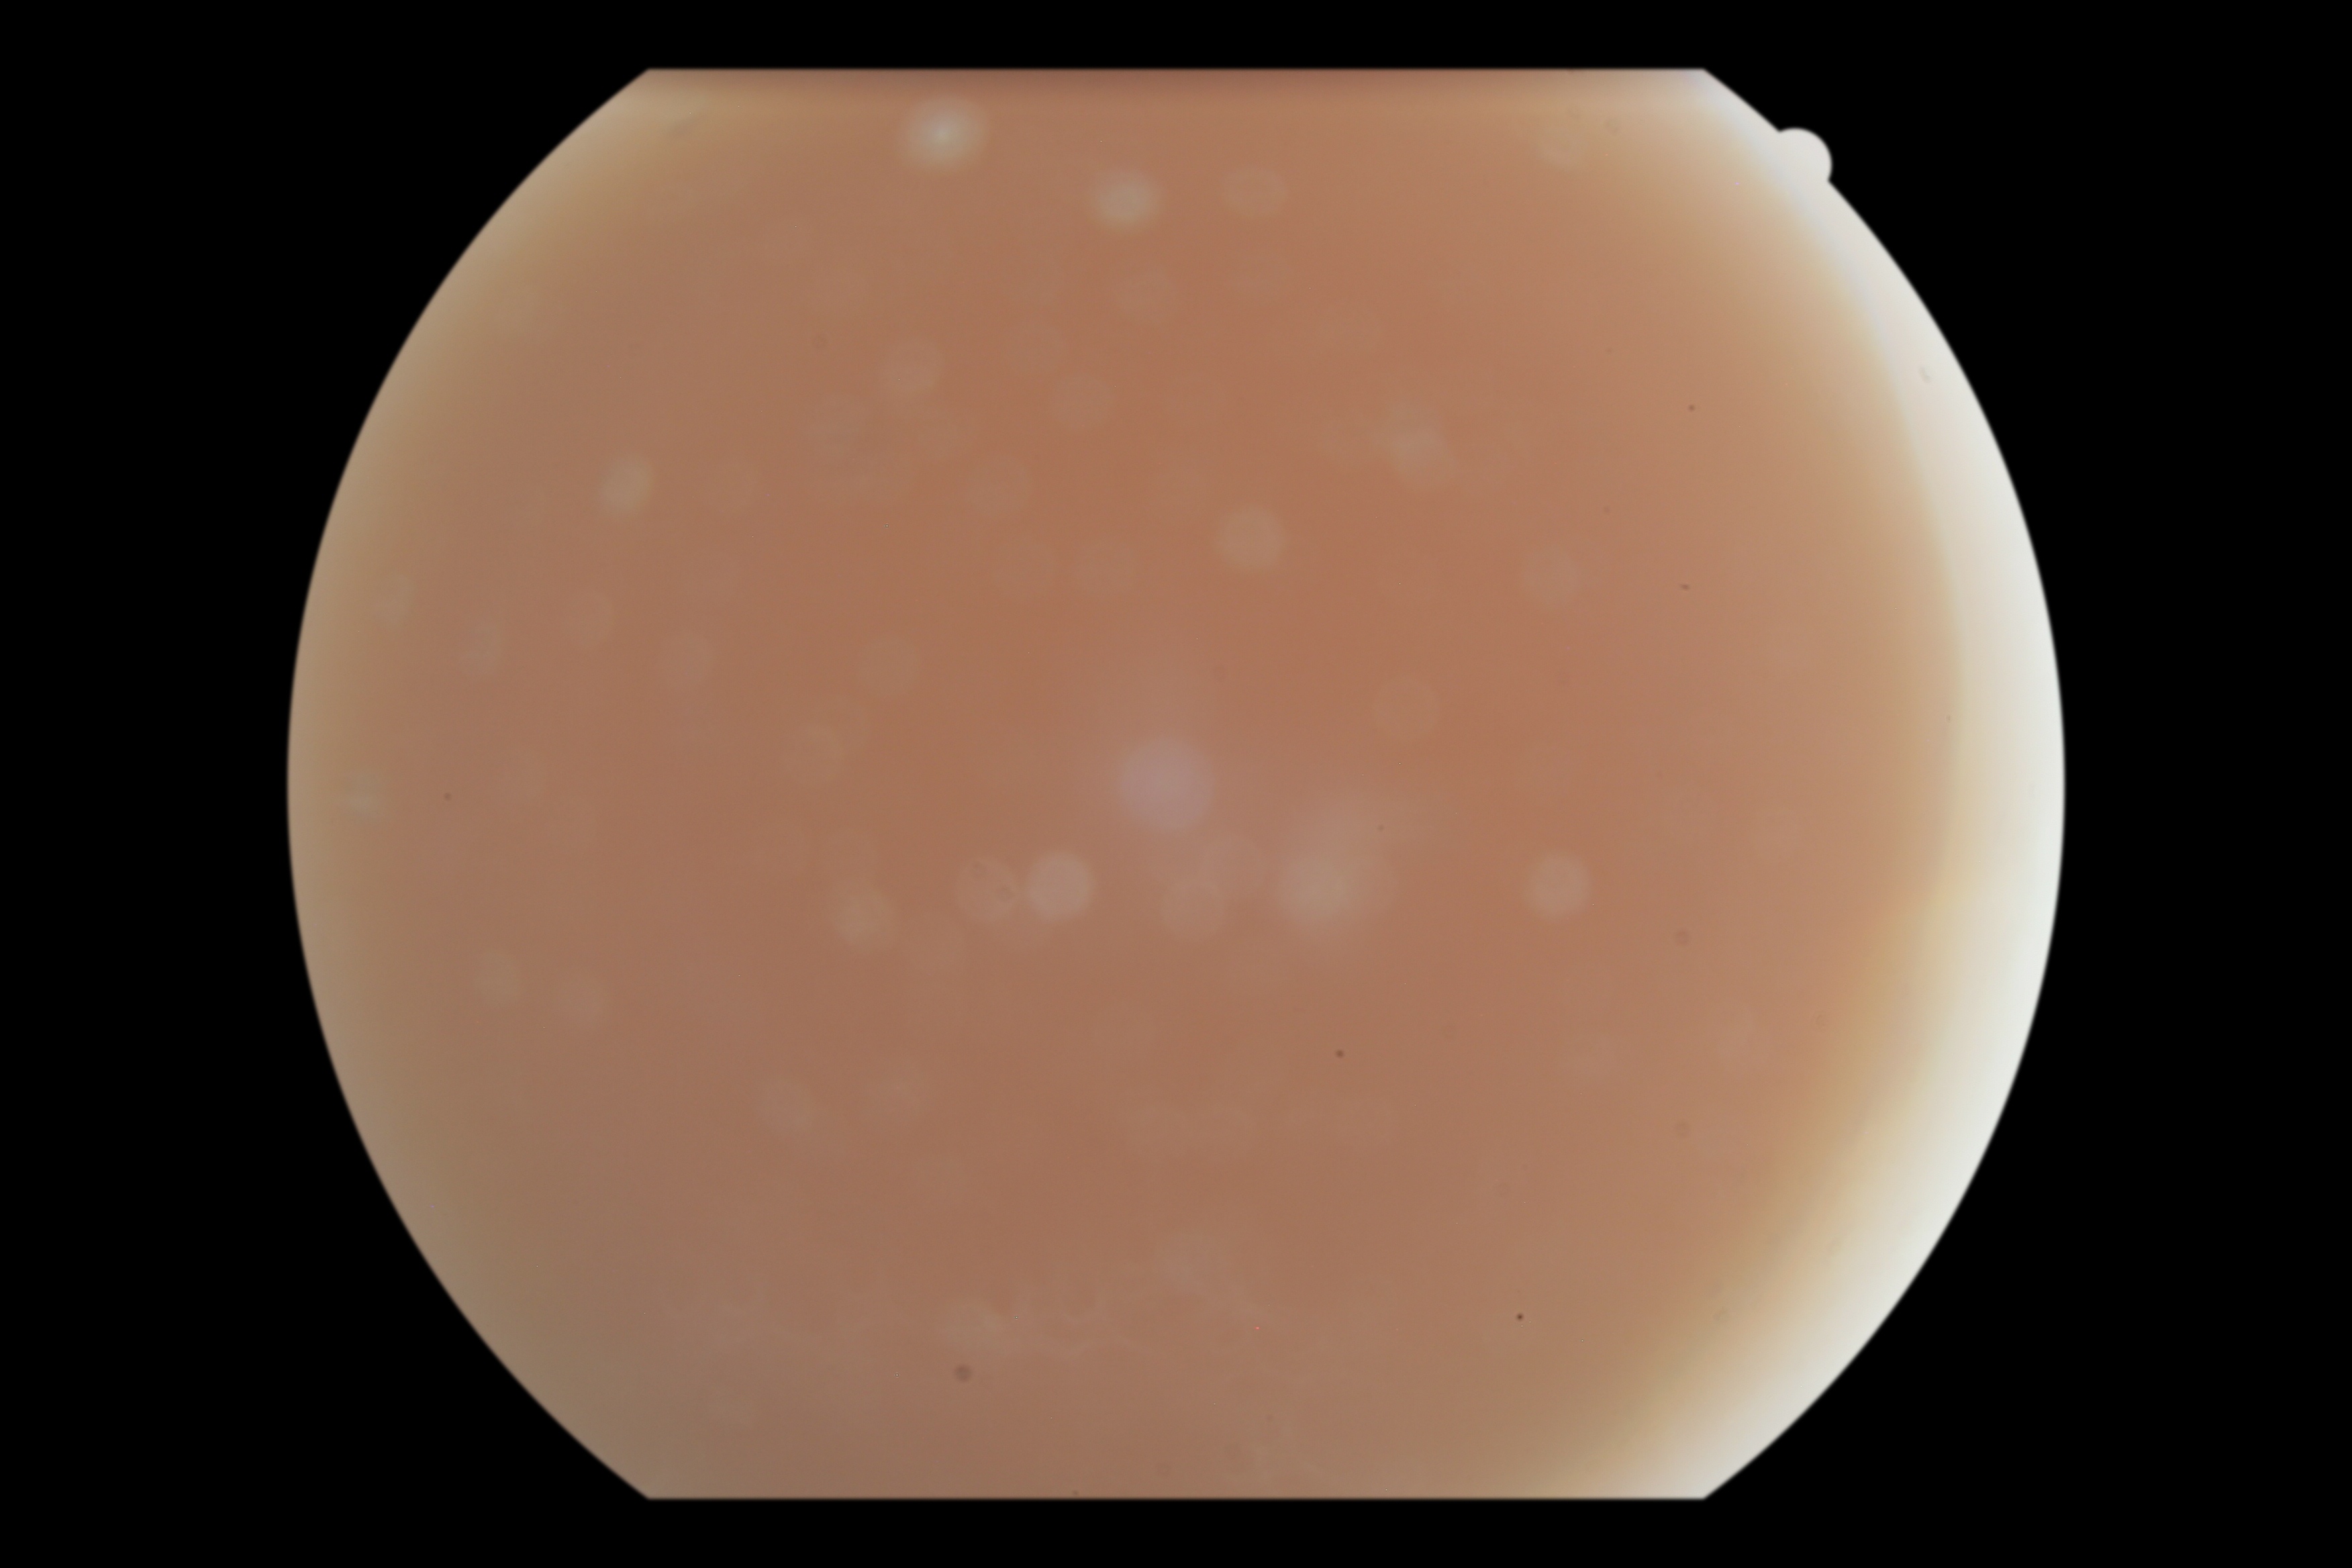
image quality: too poor for DR grading
DR grade: ungradable due to poor image quality